Image size 640x480. Wide-field fundus photograph from neonatal ROP screening
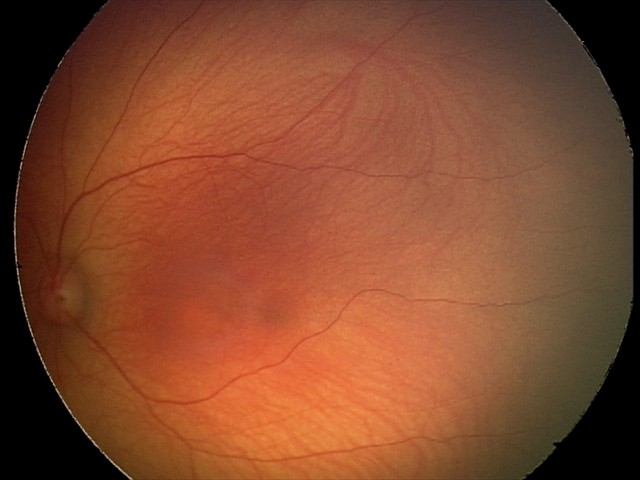

Assessment: normal retinal appearance.